Camera: Phoenix ICON (100° FOV). Infant wide-field retinal image. 1240 by 1240 pixels — 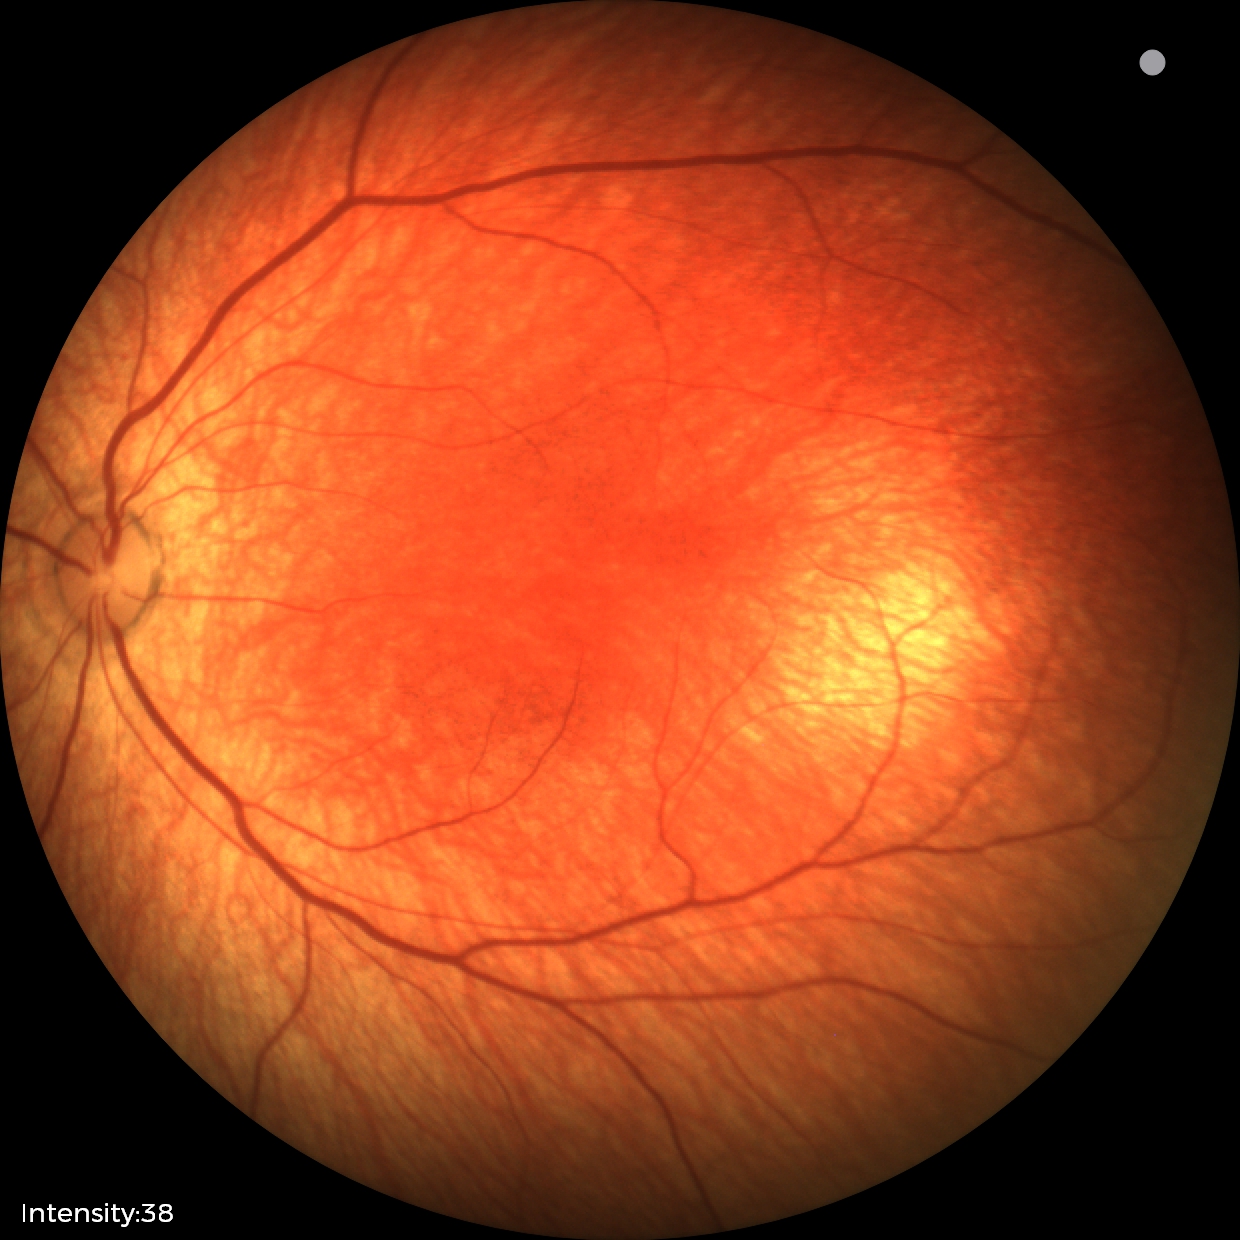
Screening diagnosis: normal fundus examination.